NIDEK AFC-230 fundus camera, retinal fundus photograph, 45-degree field of view, modified Davis classification, 848x848px:
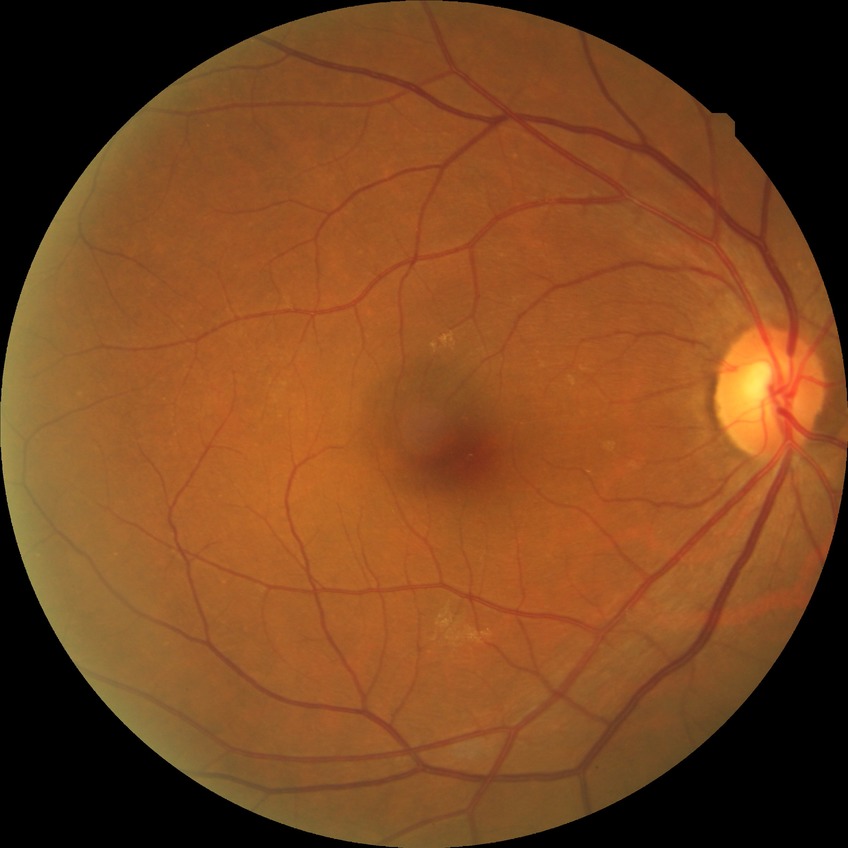 Diabetic retinopathy (DR) is no diabetic retinopathy (NDR).